Wide-field fundus photograph of an infant; 1240x1240; captured with the Phoenix ICON (100° field of view):
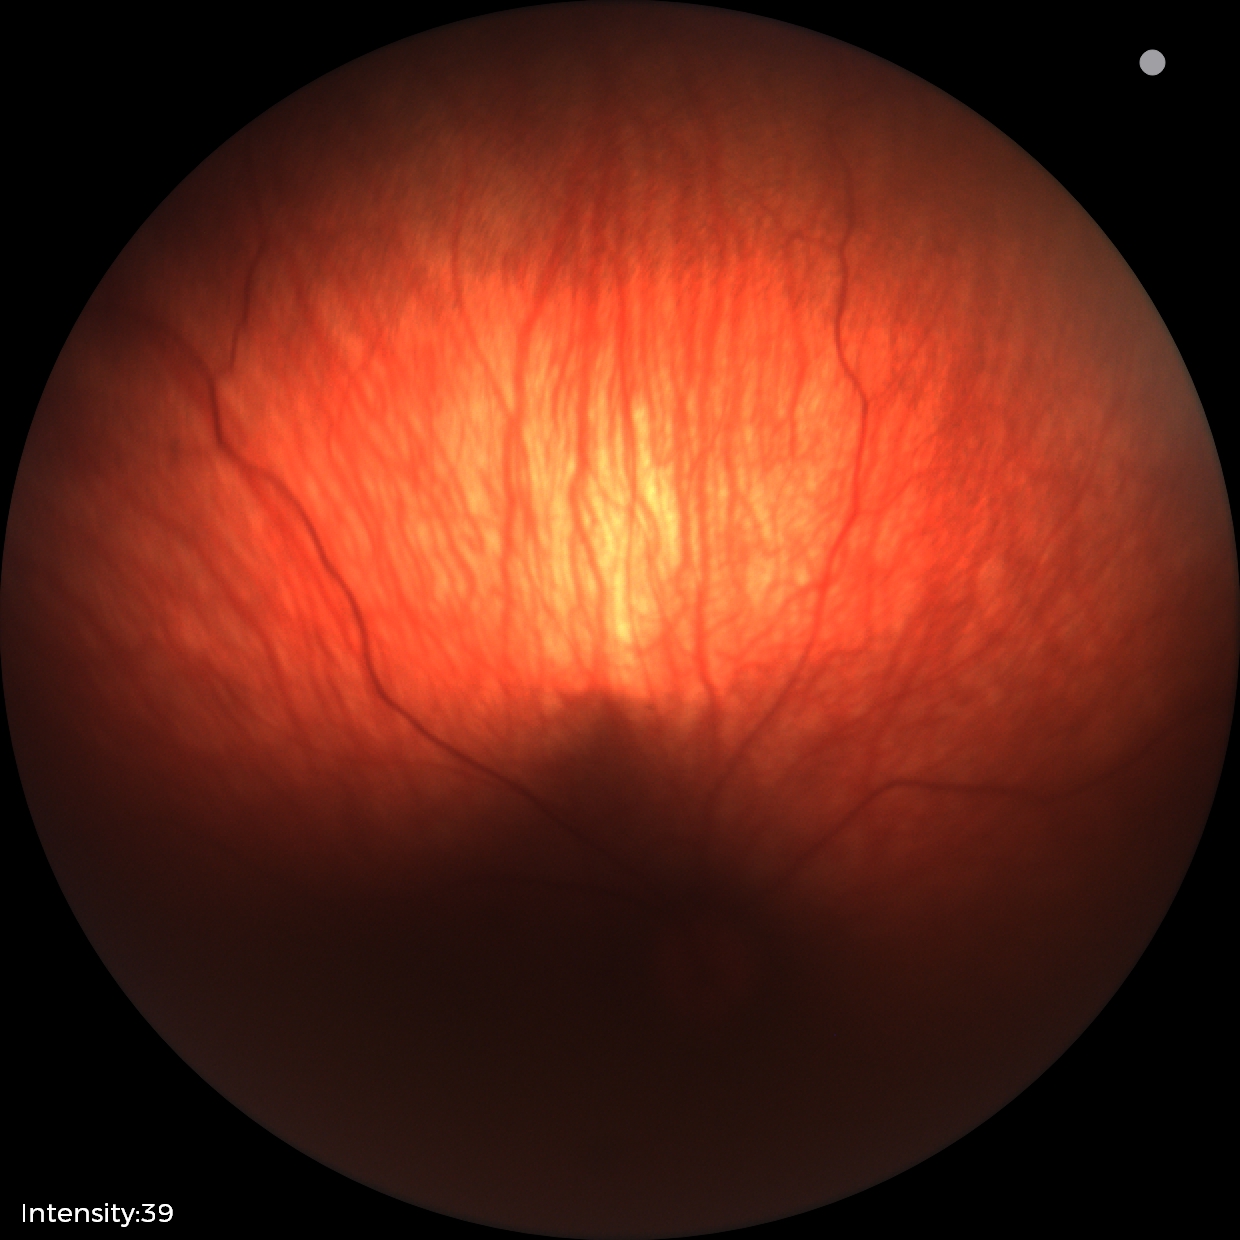 Impression: retinal hemorrhages.